Ultra-widefield fundus photograph: 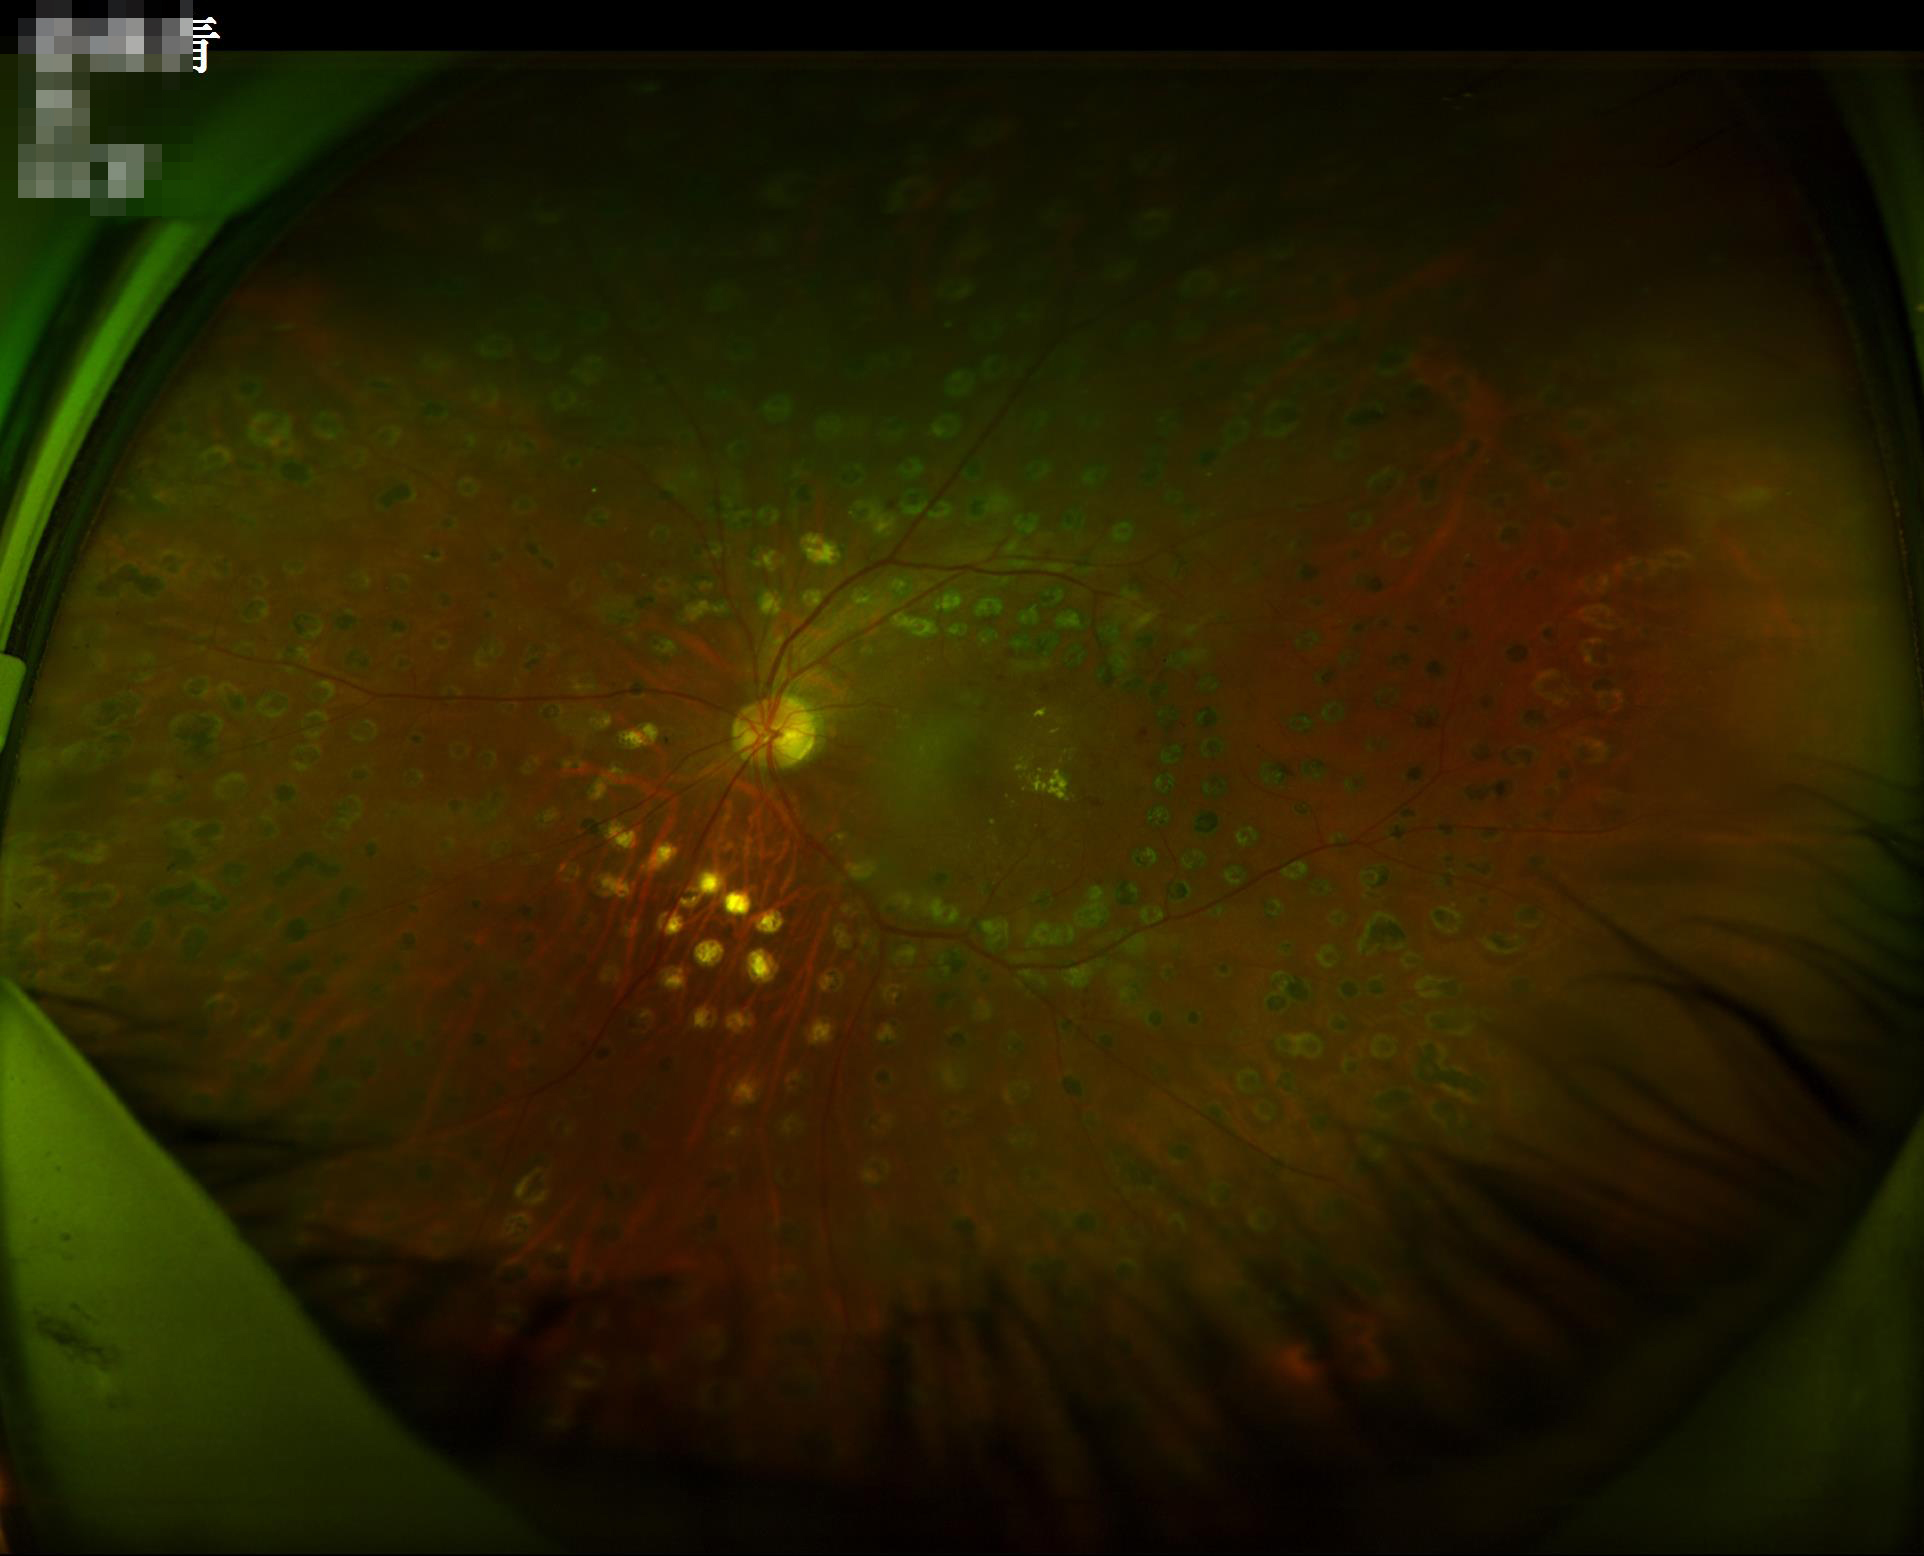

Contrast: satisfactory | Illumination/color: uneven | Clarity: clear | Overall quality: satisfactory.